Topcon TRC-50DX: 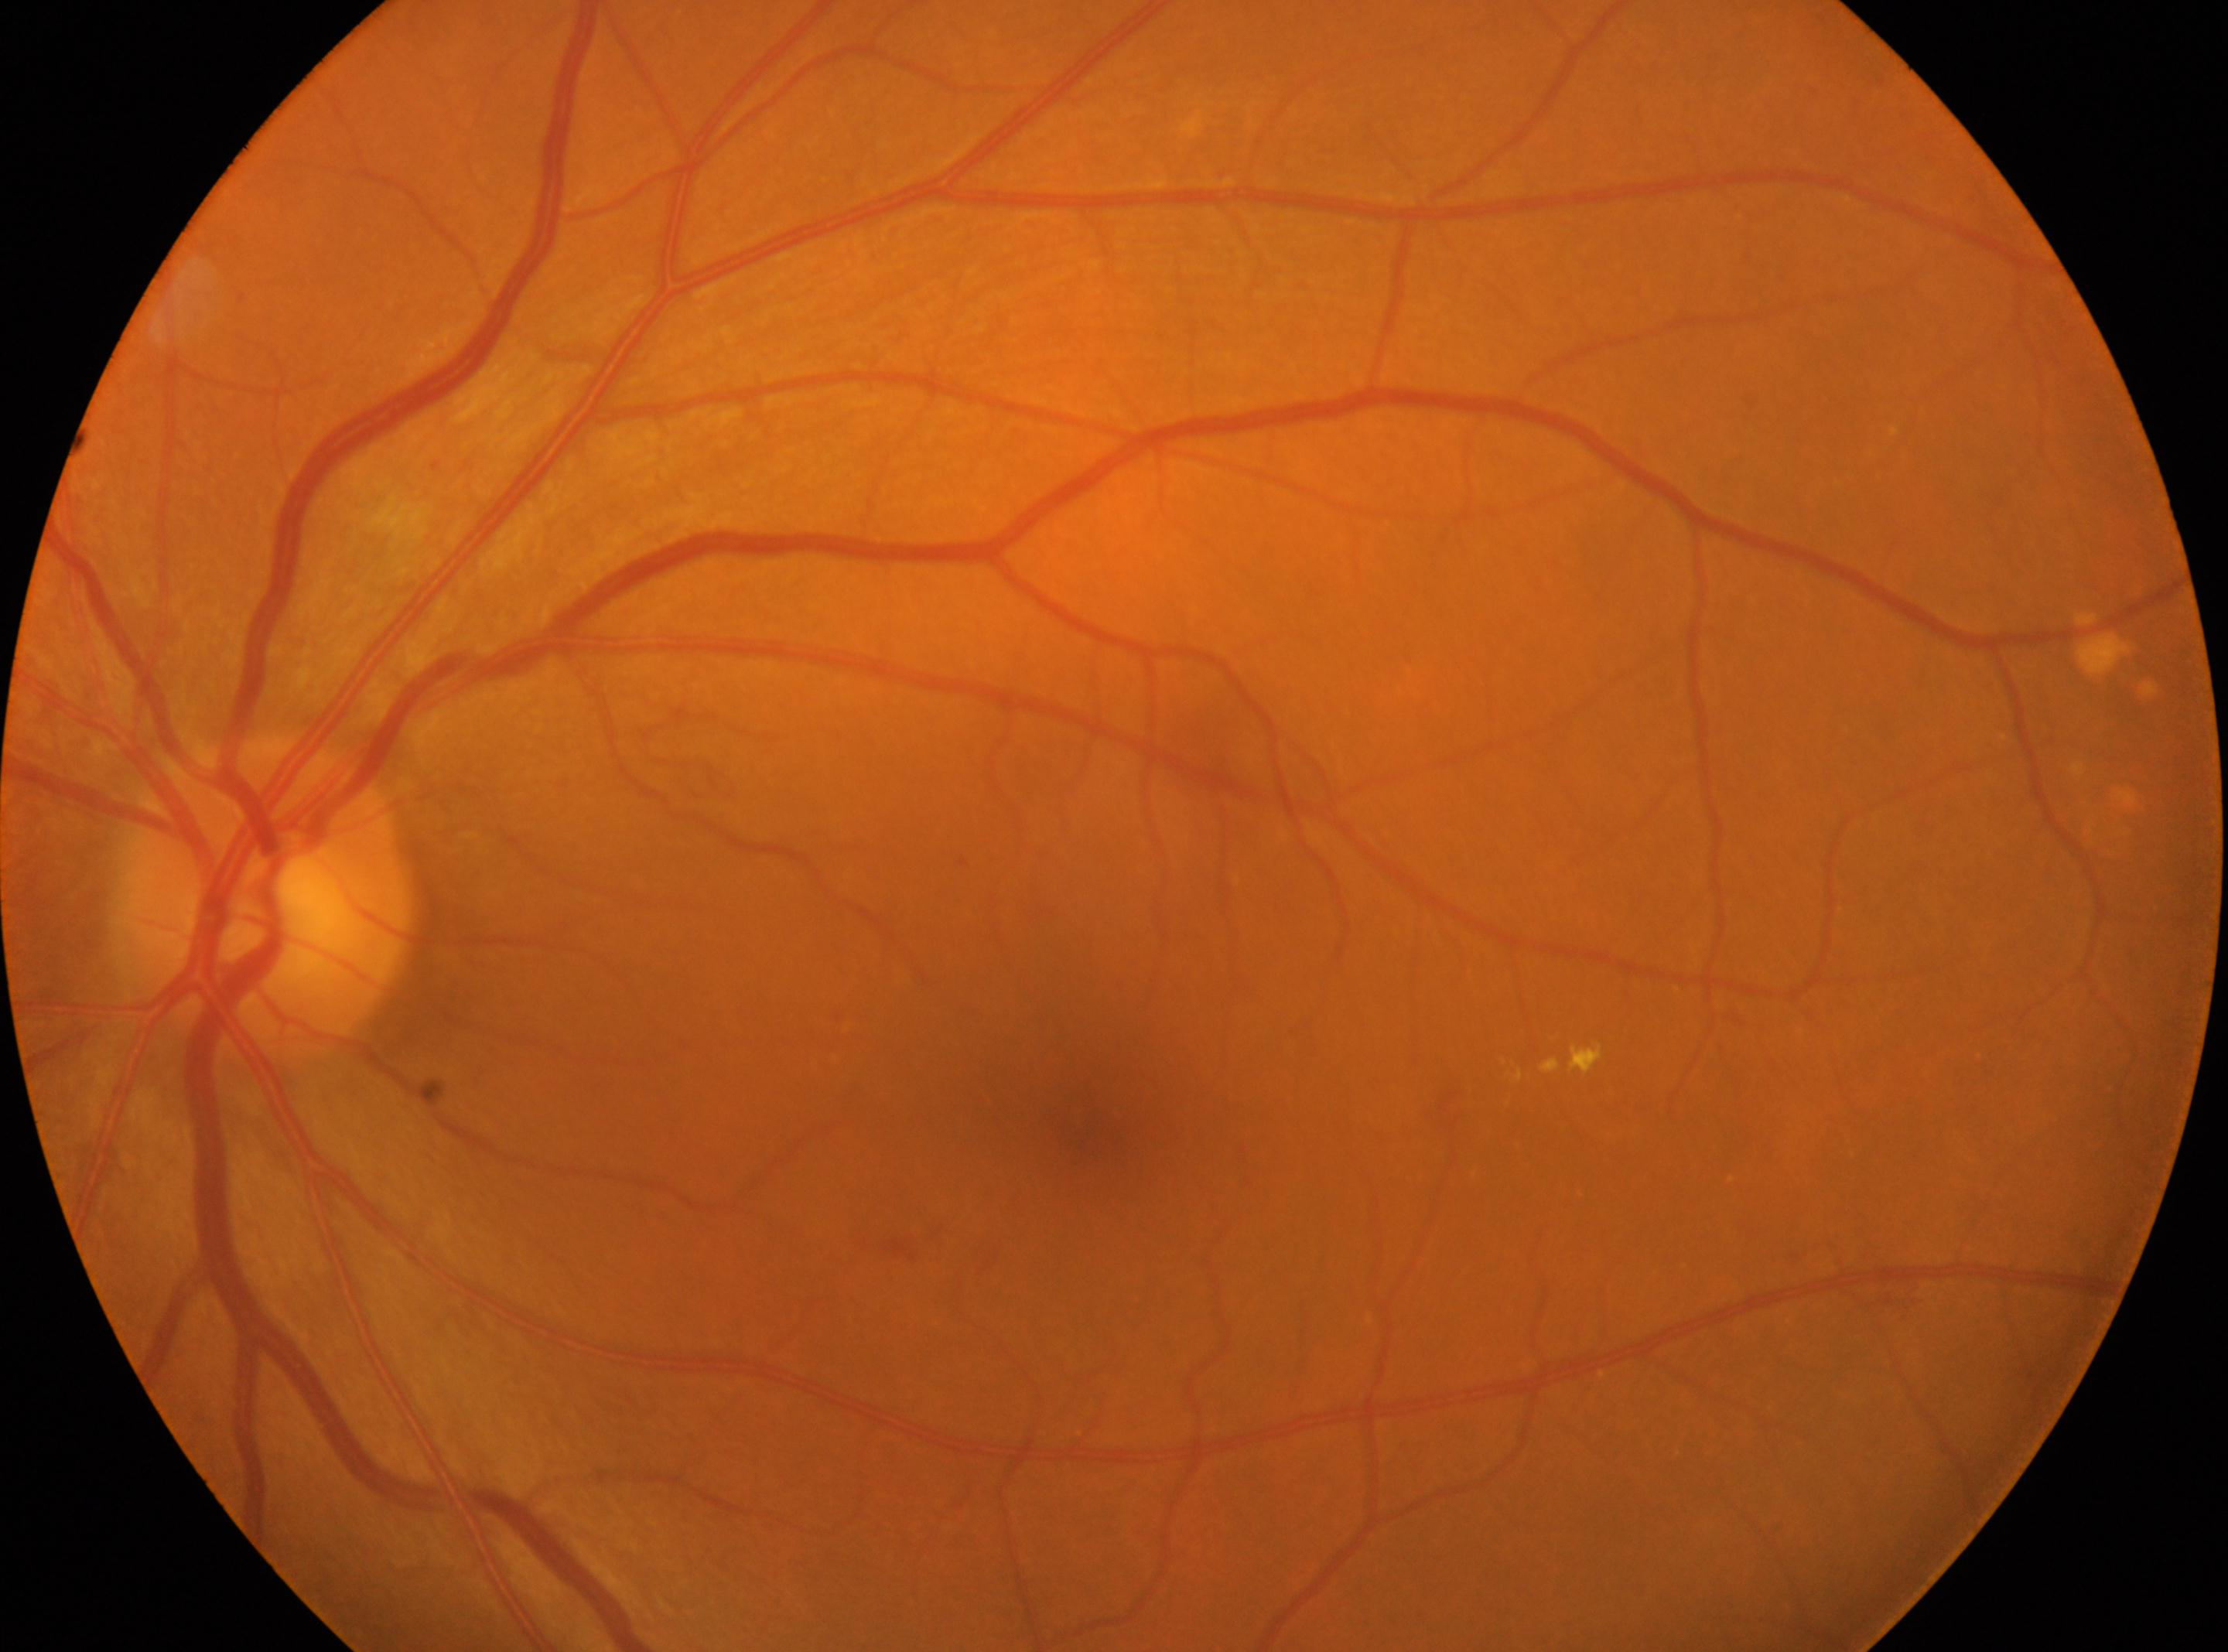 DR grade is 2 (moderate NPDR). The fovea center is at (x: 1094, y: 1132). Disc center: (x: 268, y: 899). Imaged eye: OS.